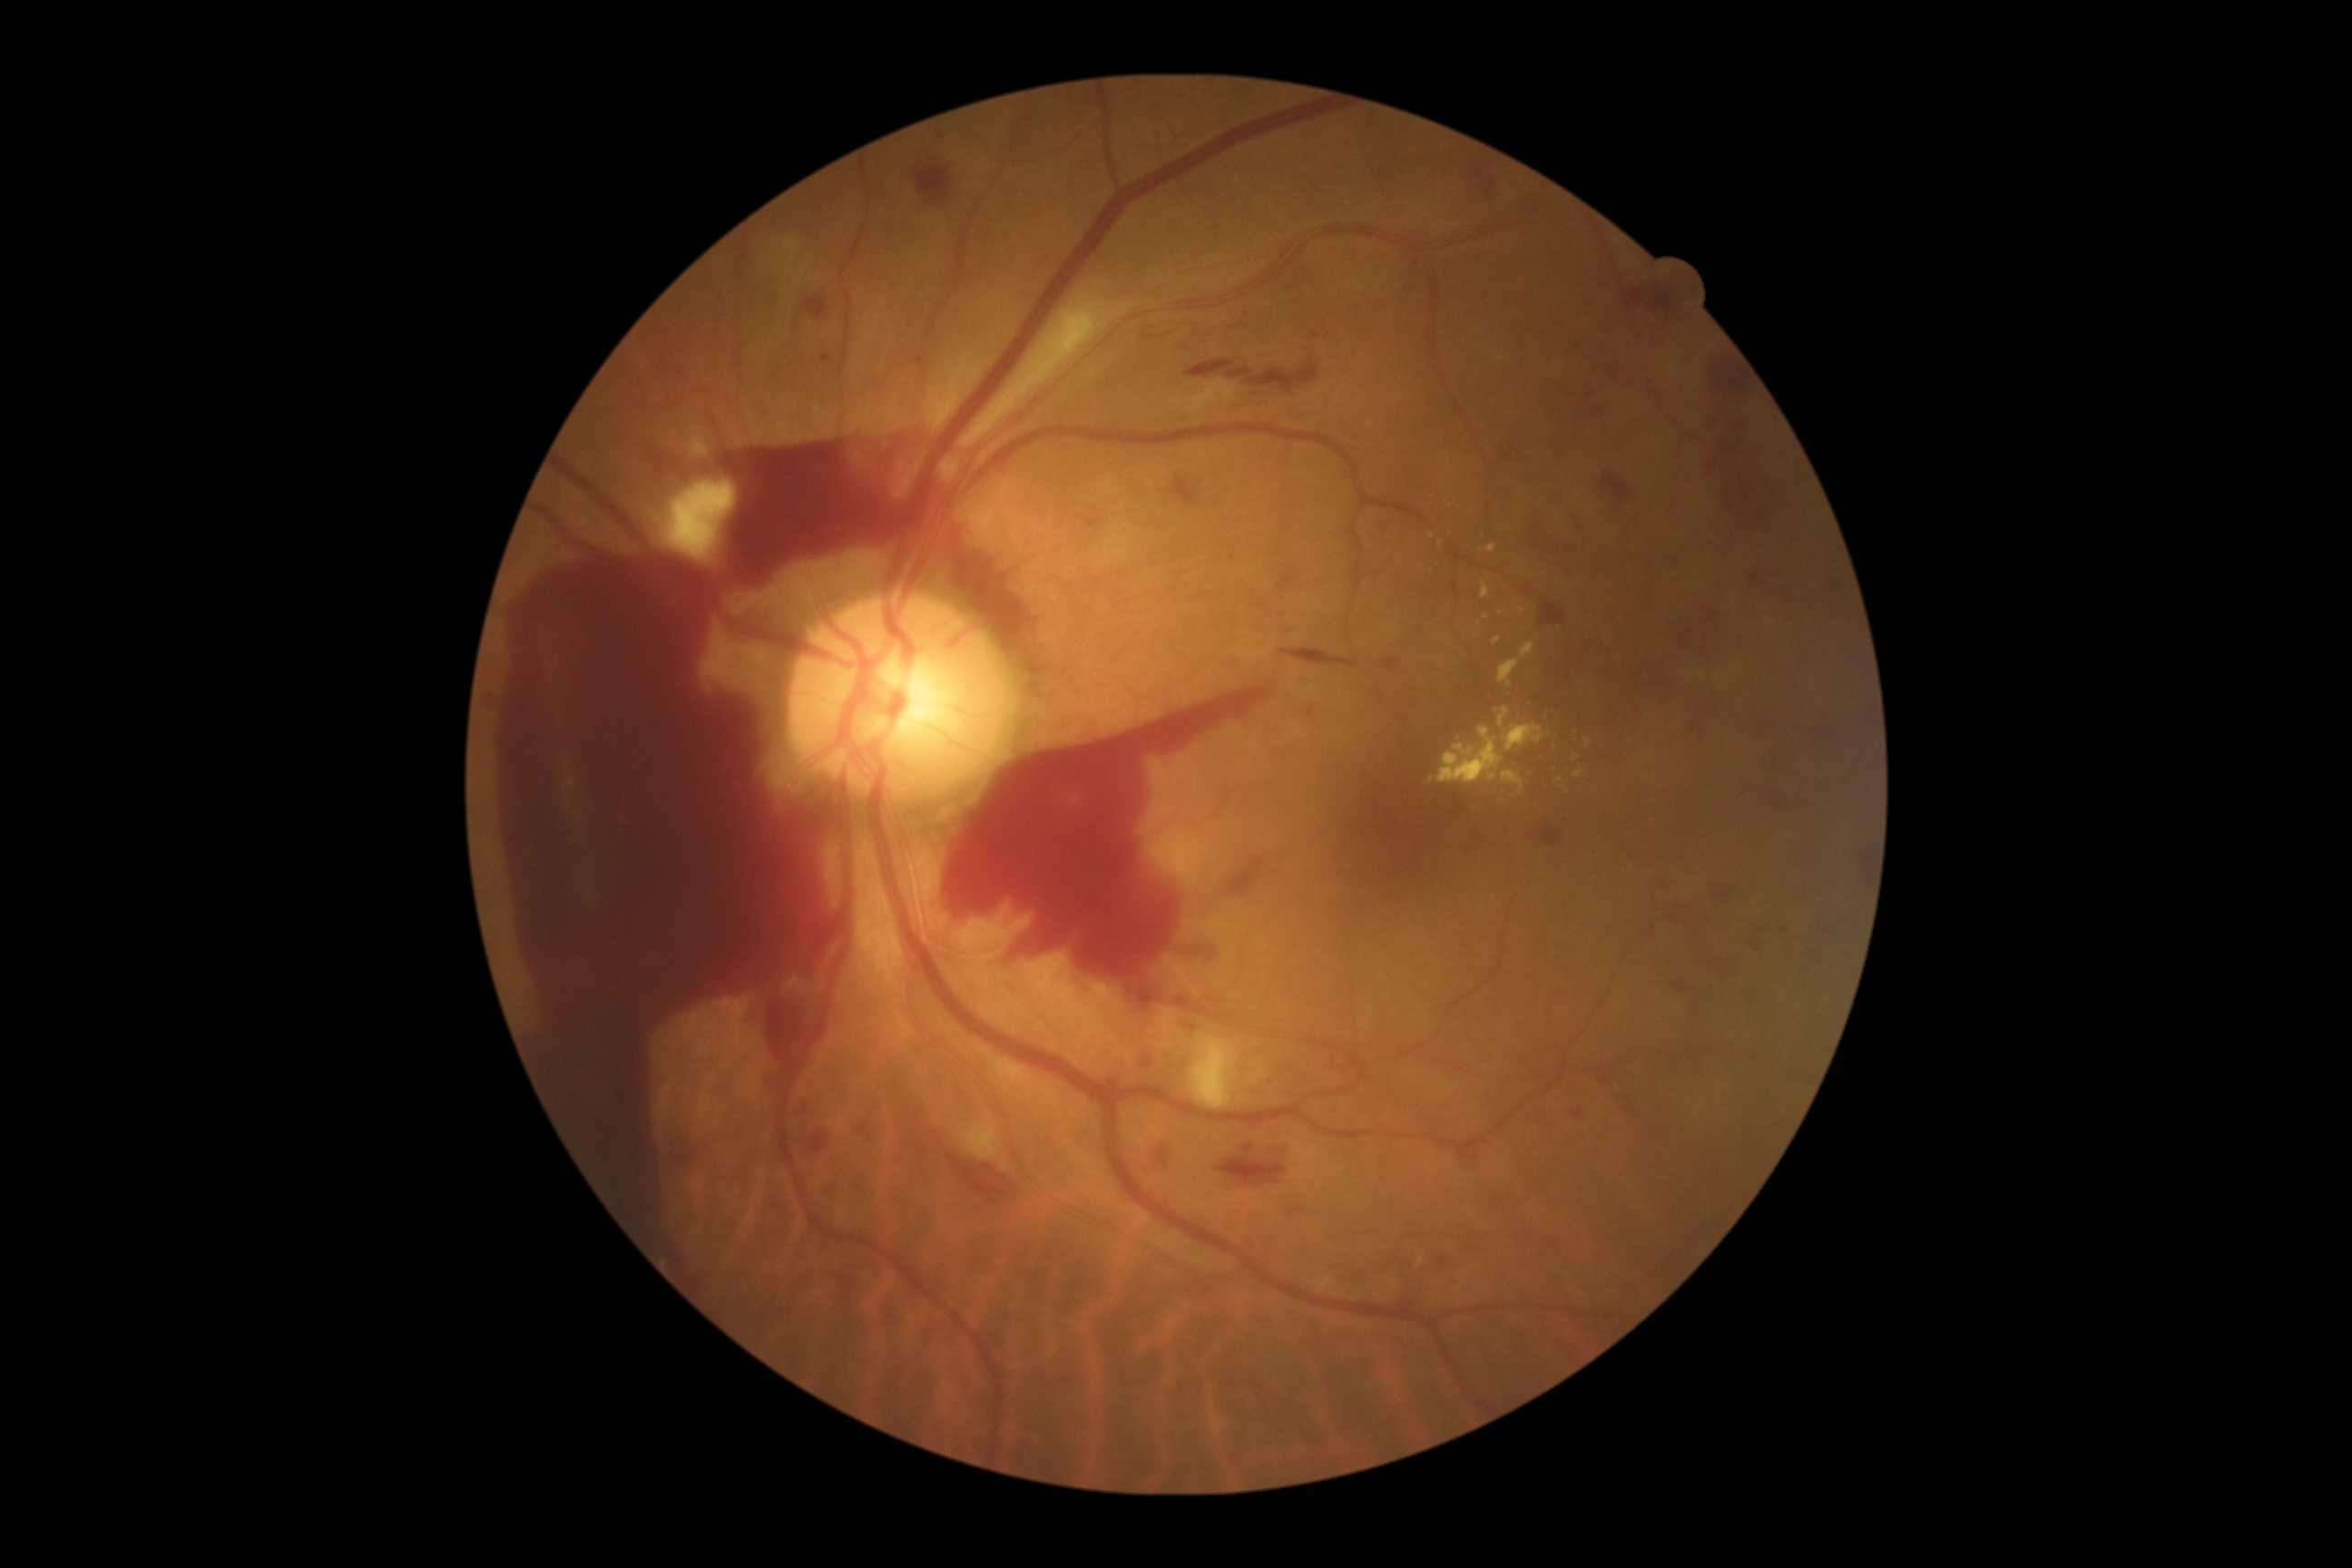
Diabetic retinopathy grade is 4 — neovascularization and/or vitreous/pre-retinal hemorrhage.